Color fundus image:
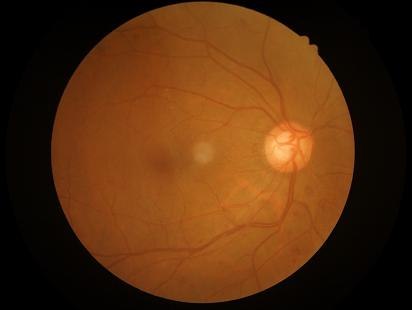

Image quality: overall: adequate; contrast: adequate; sharpness: in focus; illumination/color: satisfactory.